45° FOV.
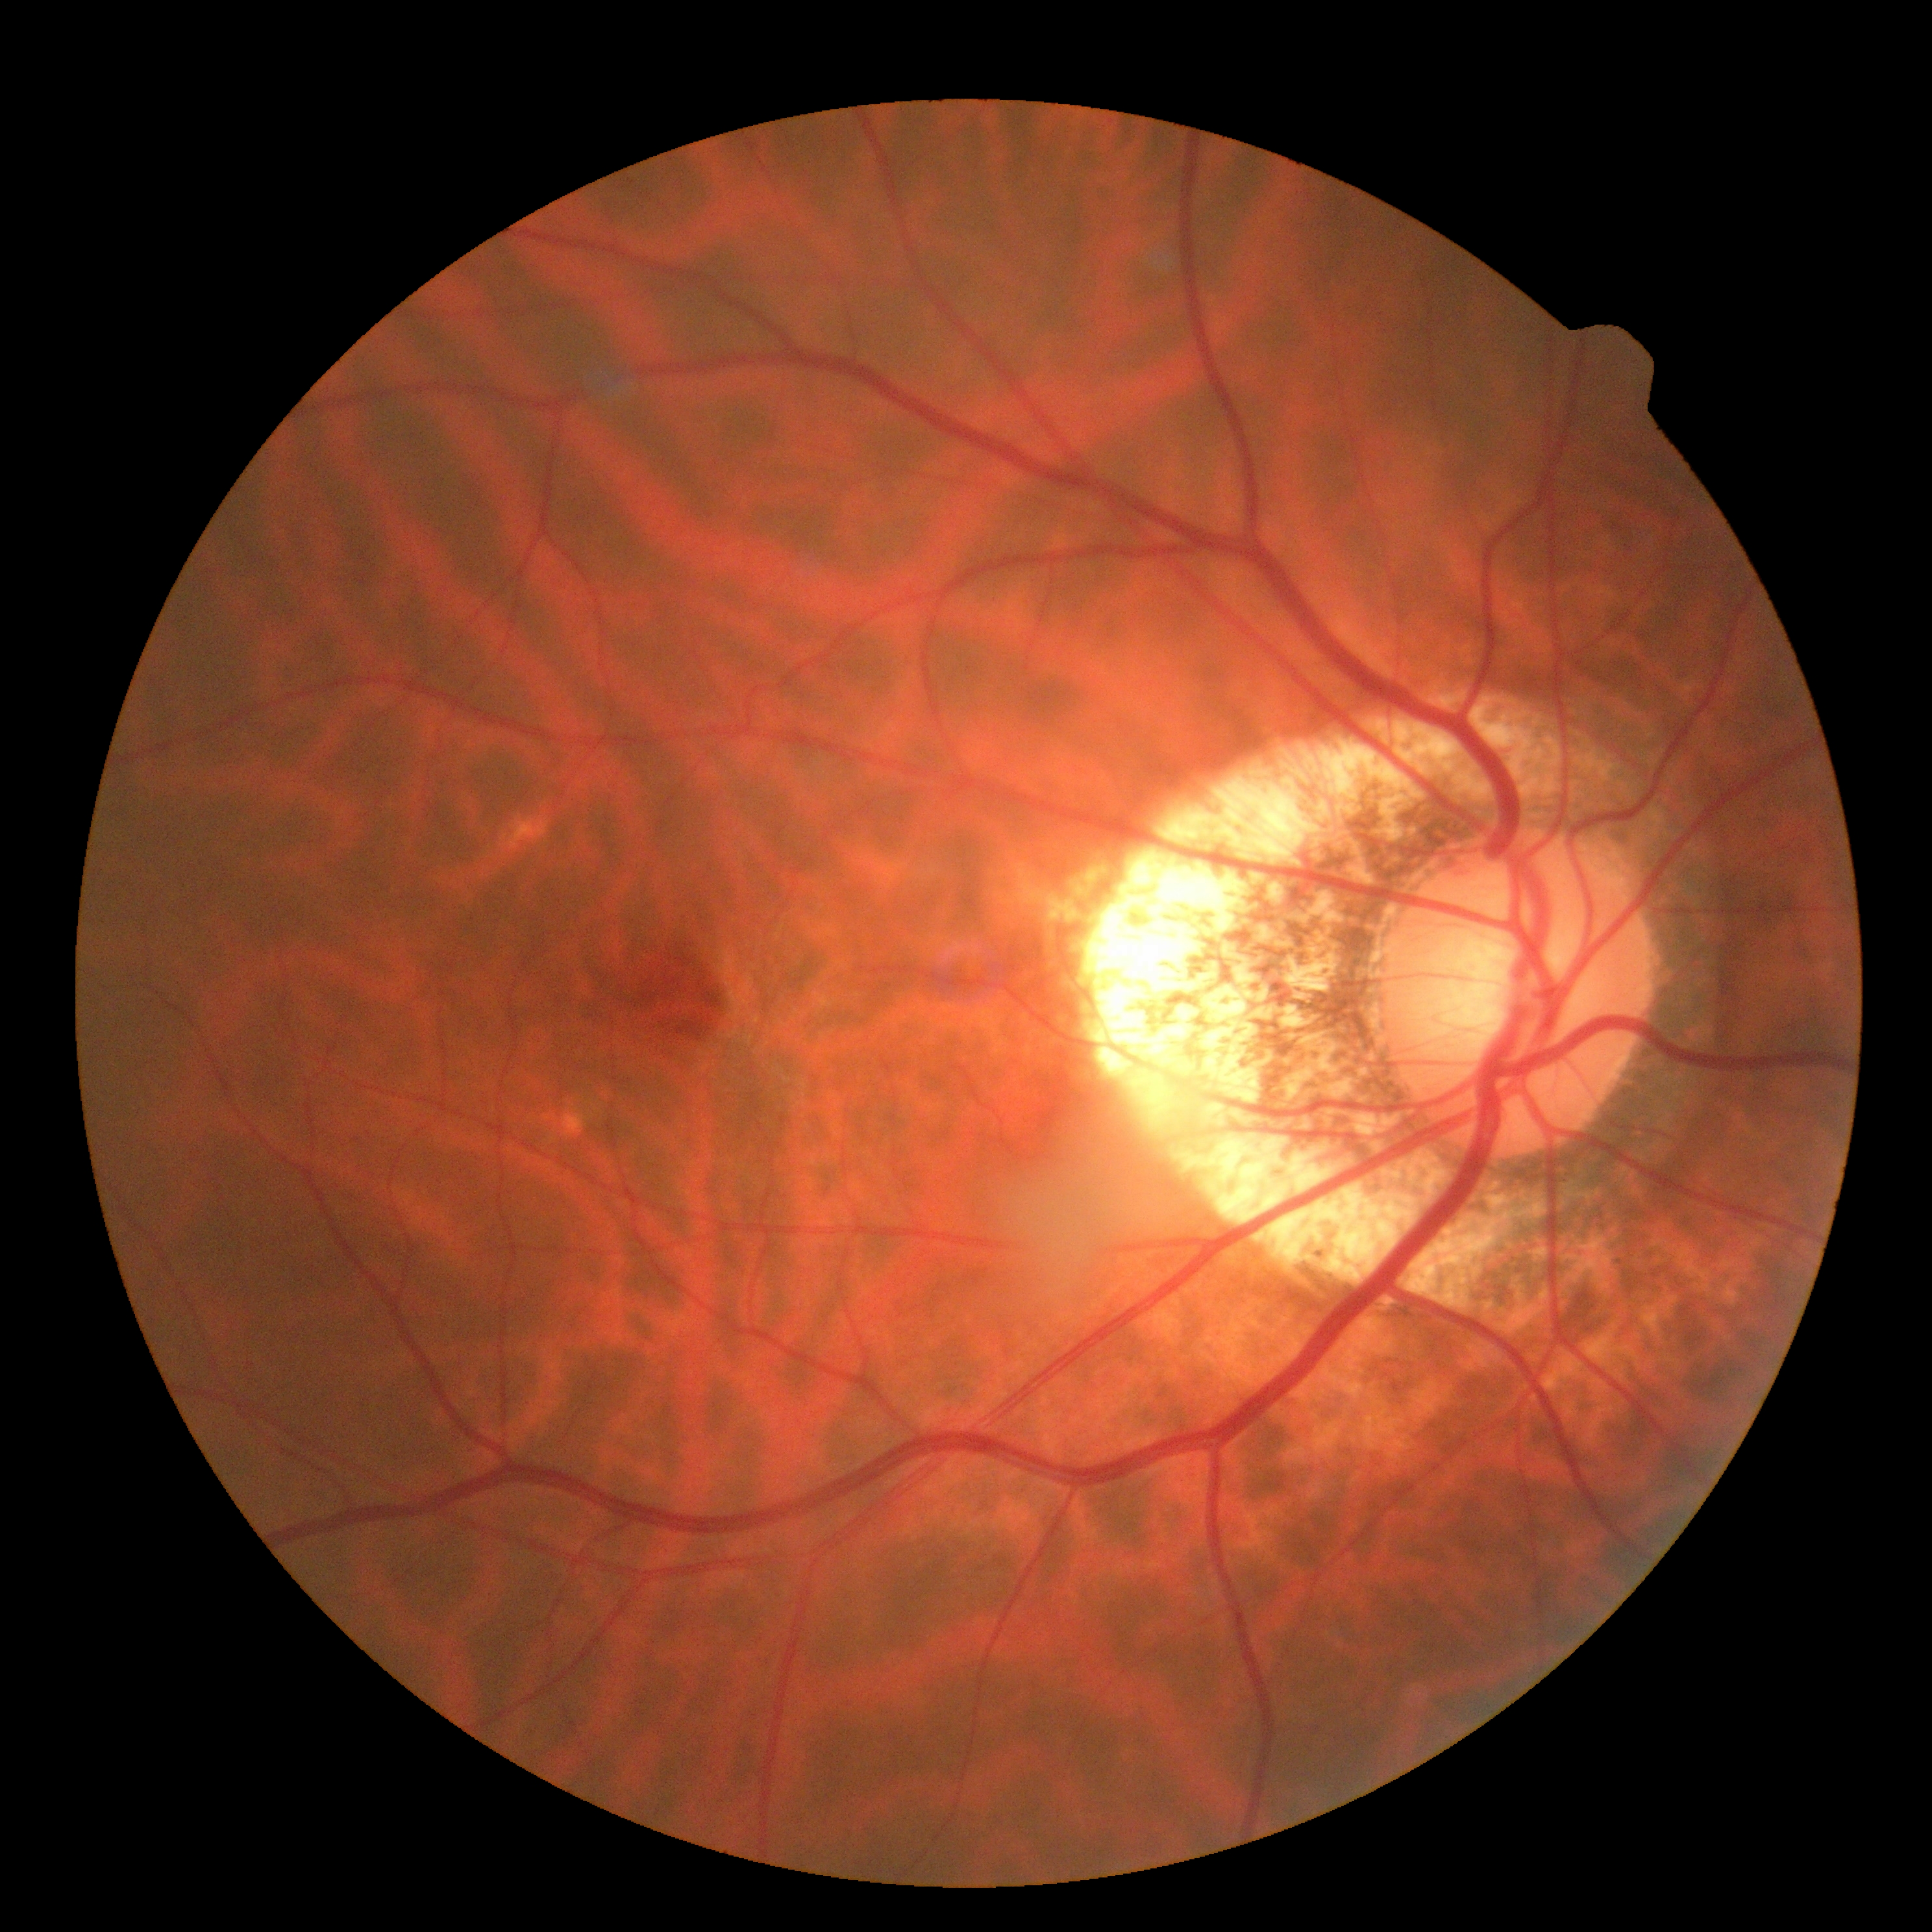 DR stage: 0 | DR impression: no signs of DR.